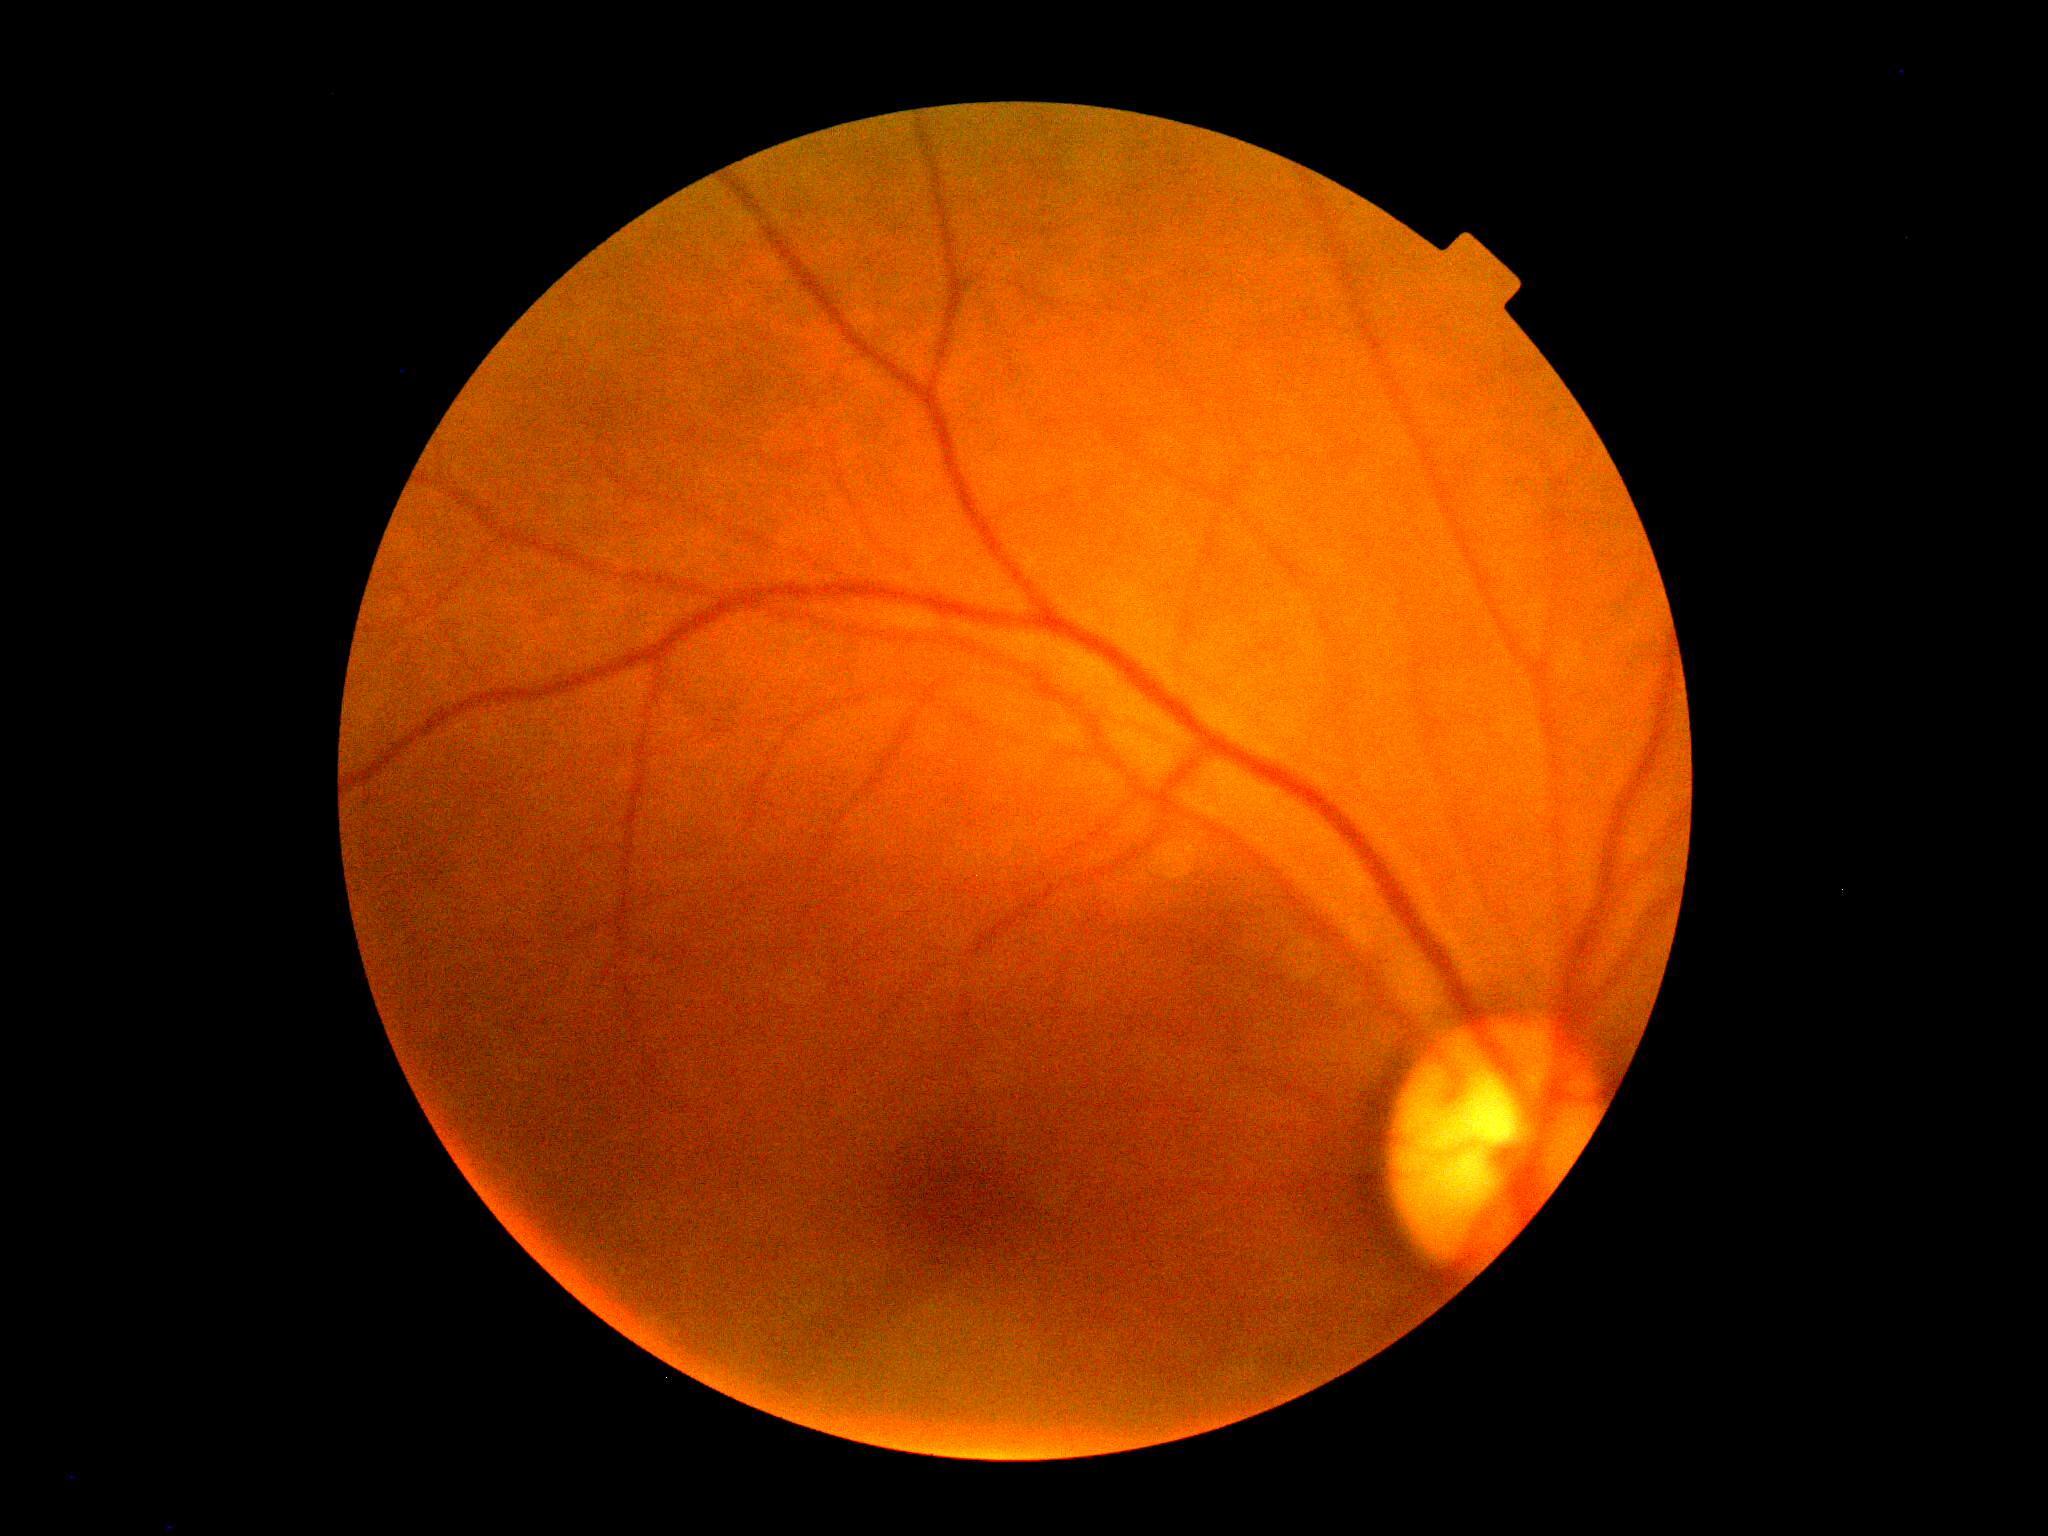
DR impression = no signs of DR
DR grade = 0